848 by 848 pixels.
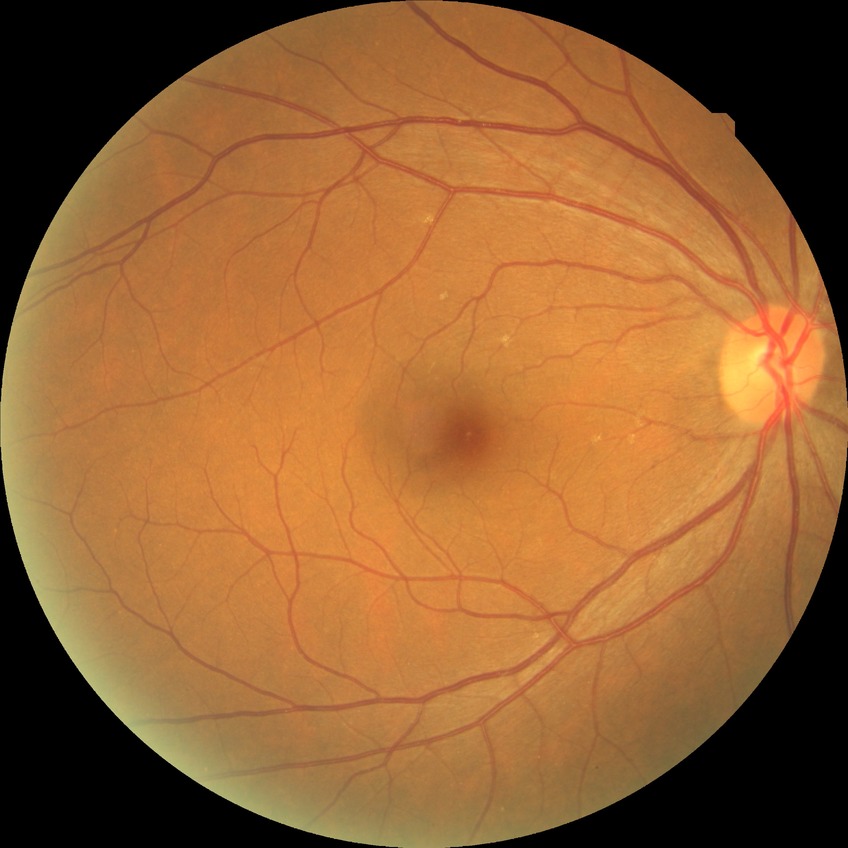

• diabetic retinopathy (DR) — no diabetic retinopathy (NDR)